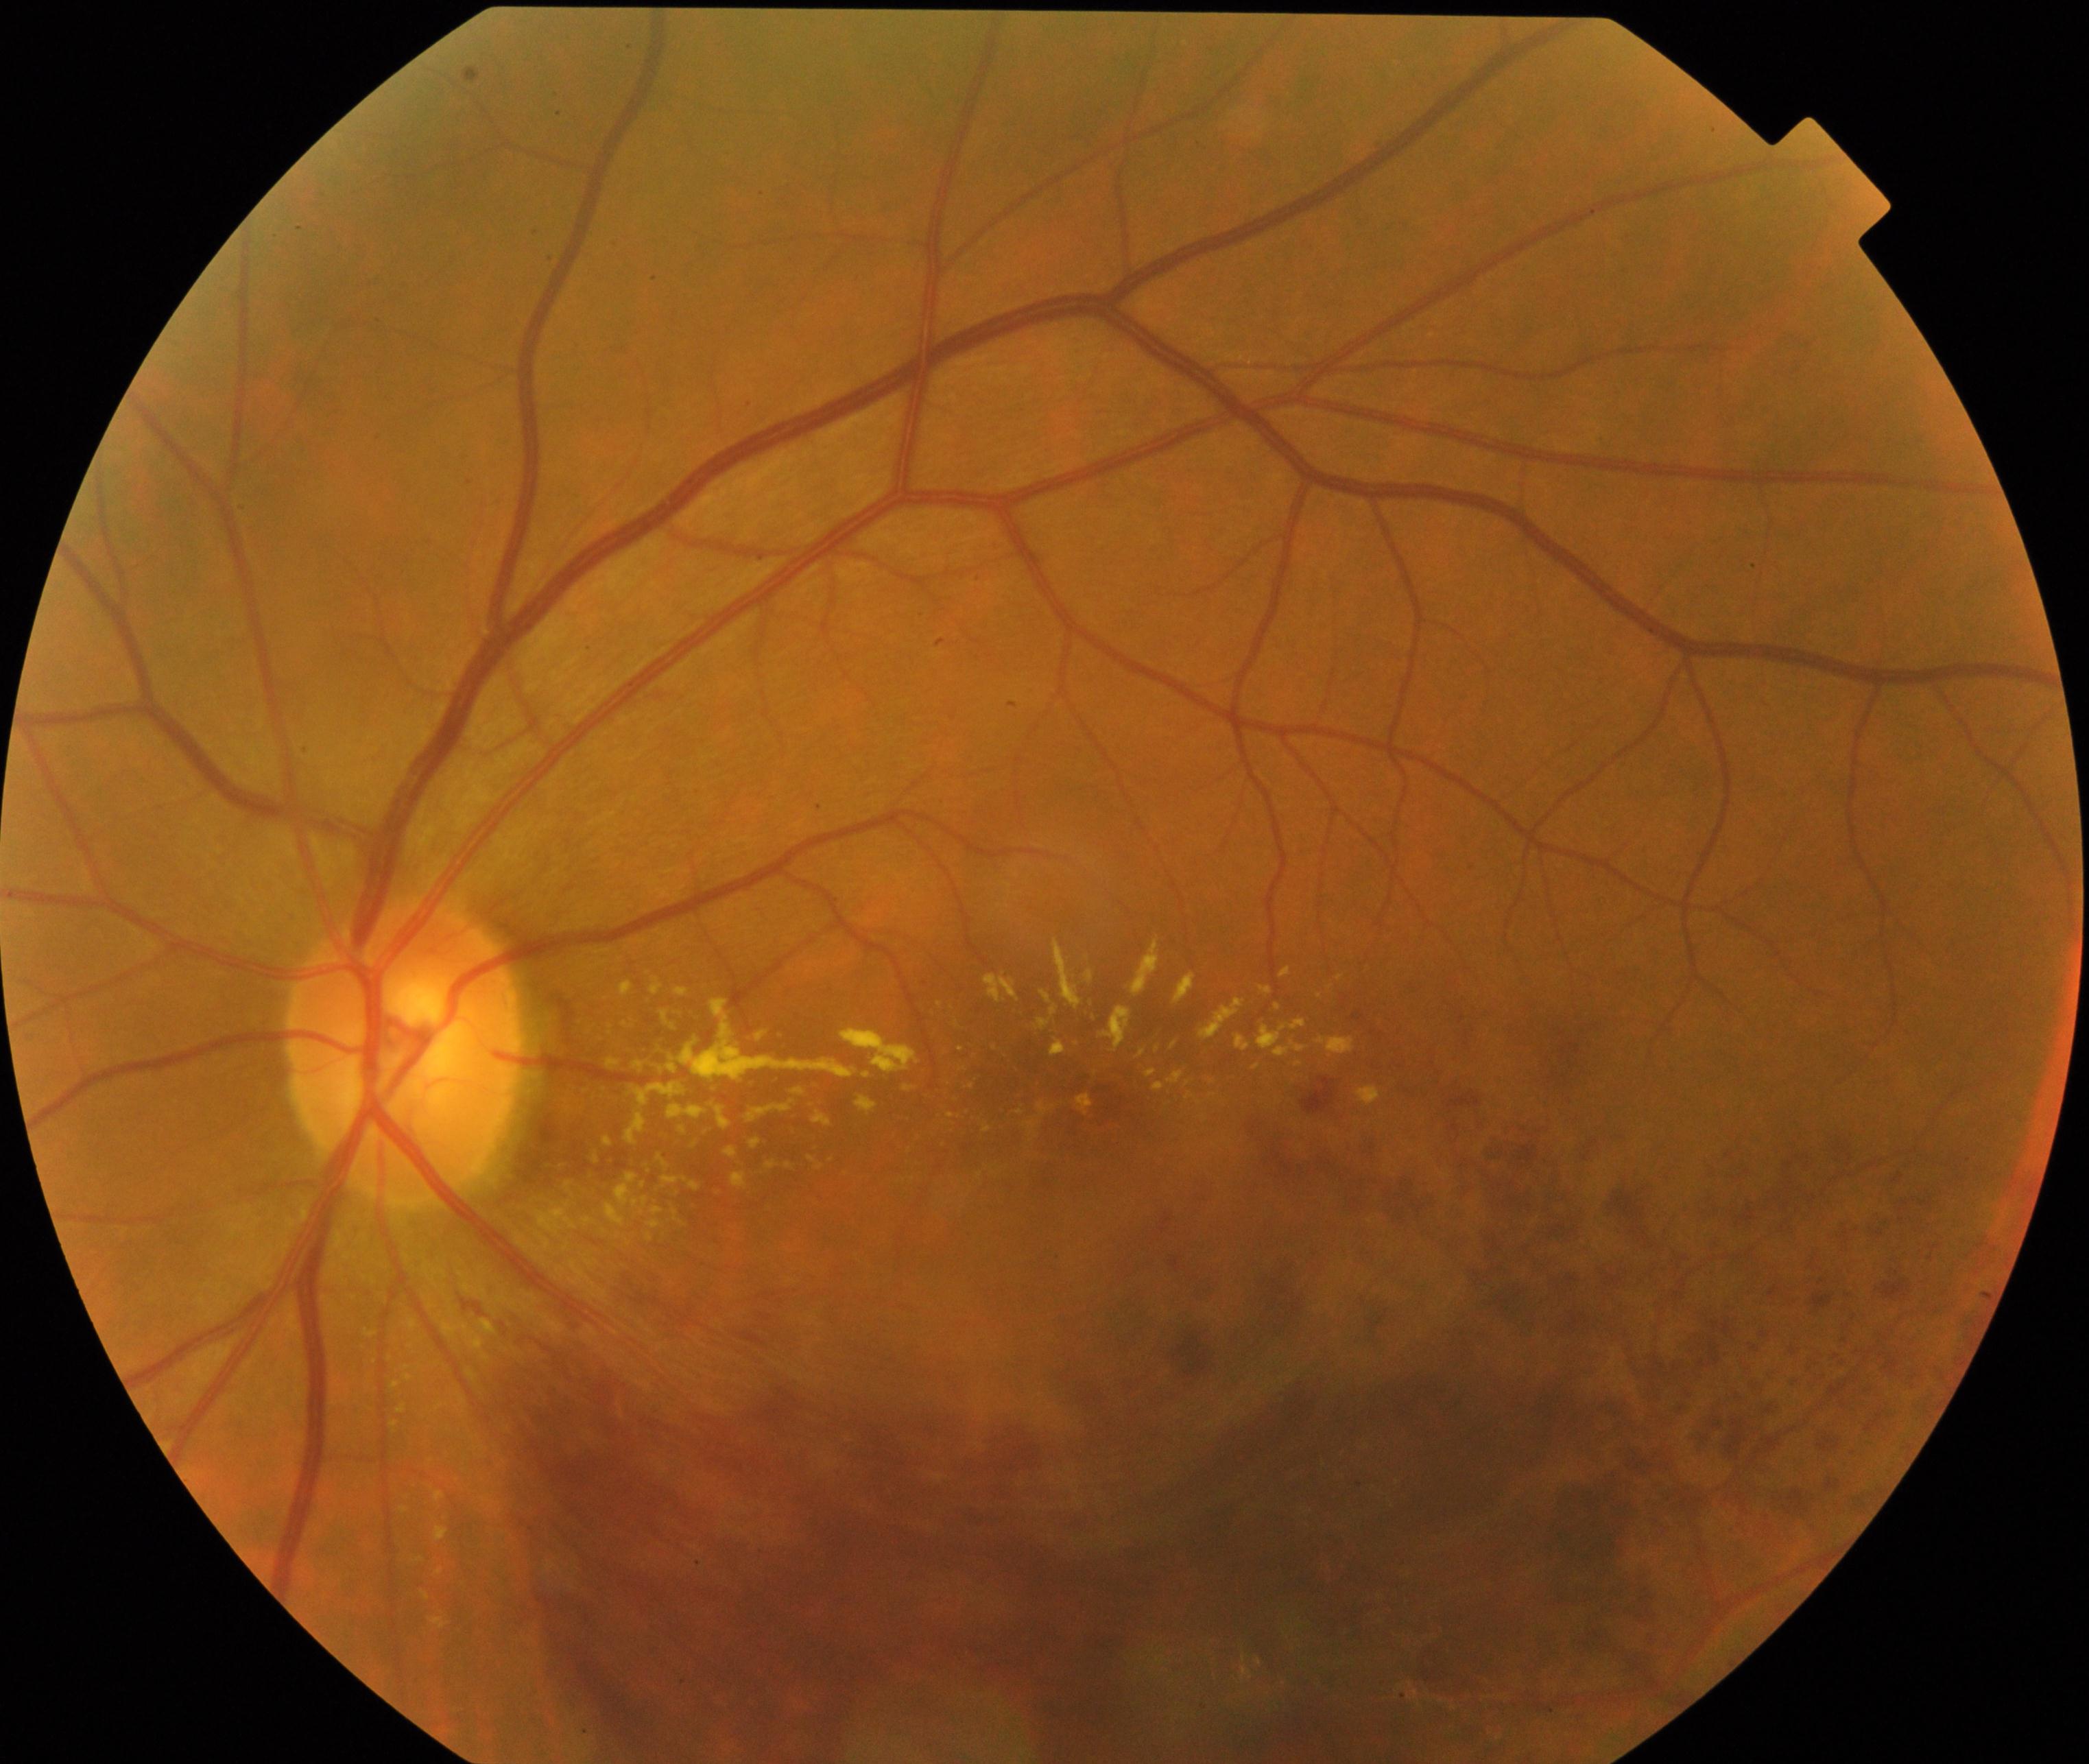 This fundus photograph shows branch retinal vein occlusion (BRVO). Defined by tortuosity and dilatation of affected veins, with dot, blot, and flame hemorrhages, sometimes with cotton-wool spots or hard exudates.